Clarity RetCam 3, 130° FOV · infant wide-field fundus photograph:
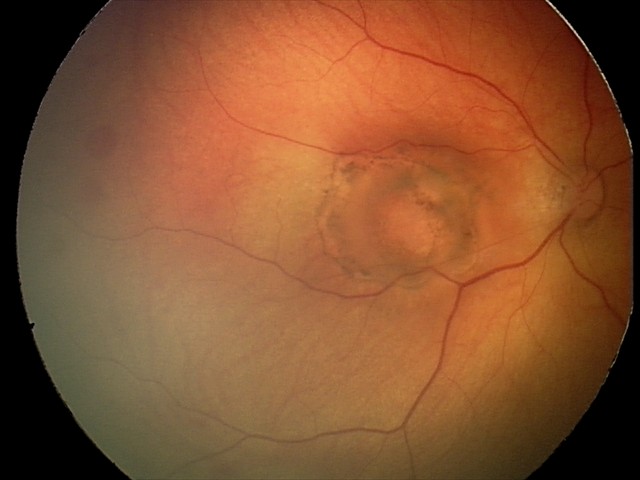

From an examination with diagnosis of toxoplasmosis chorioretinitis.